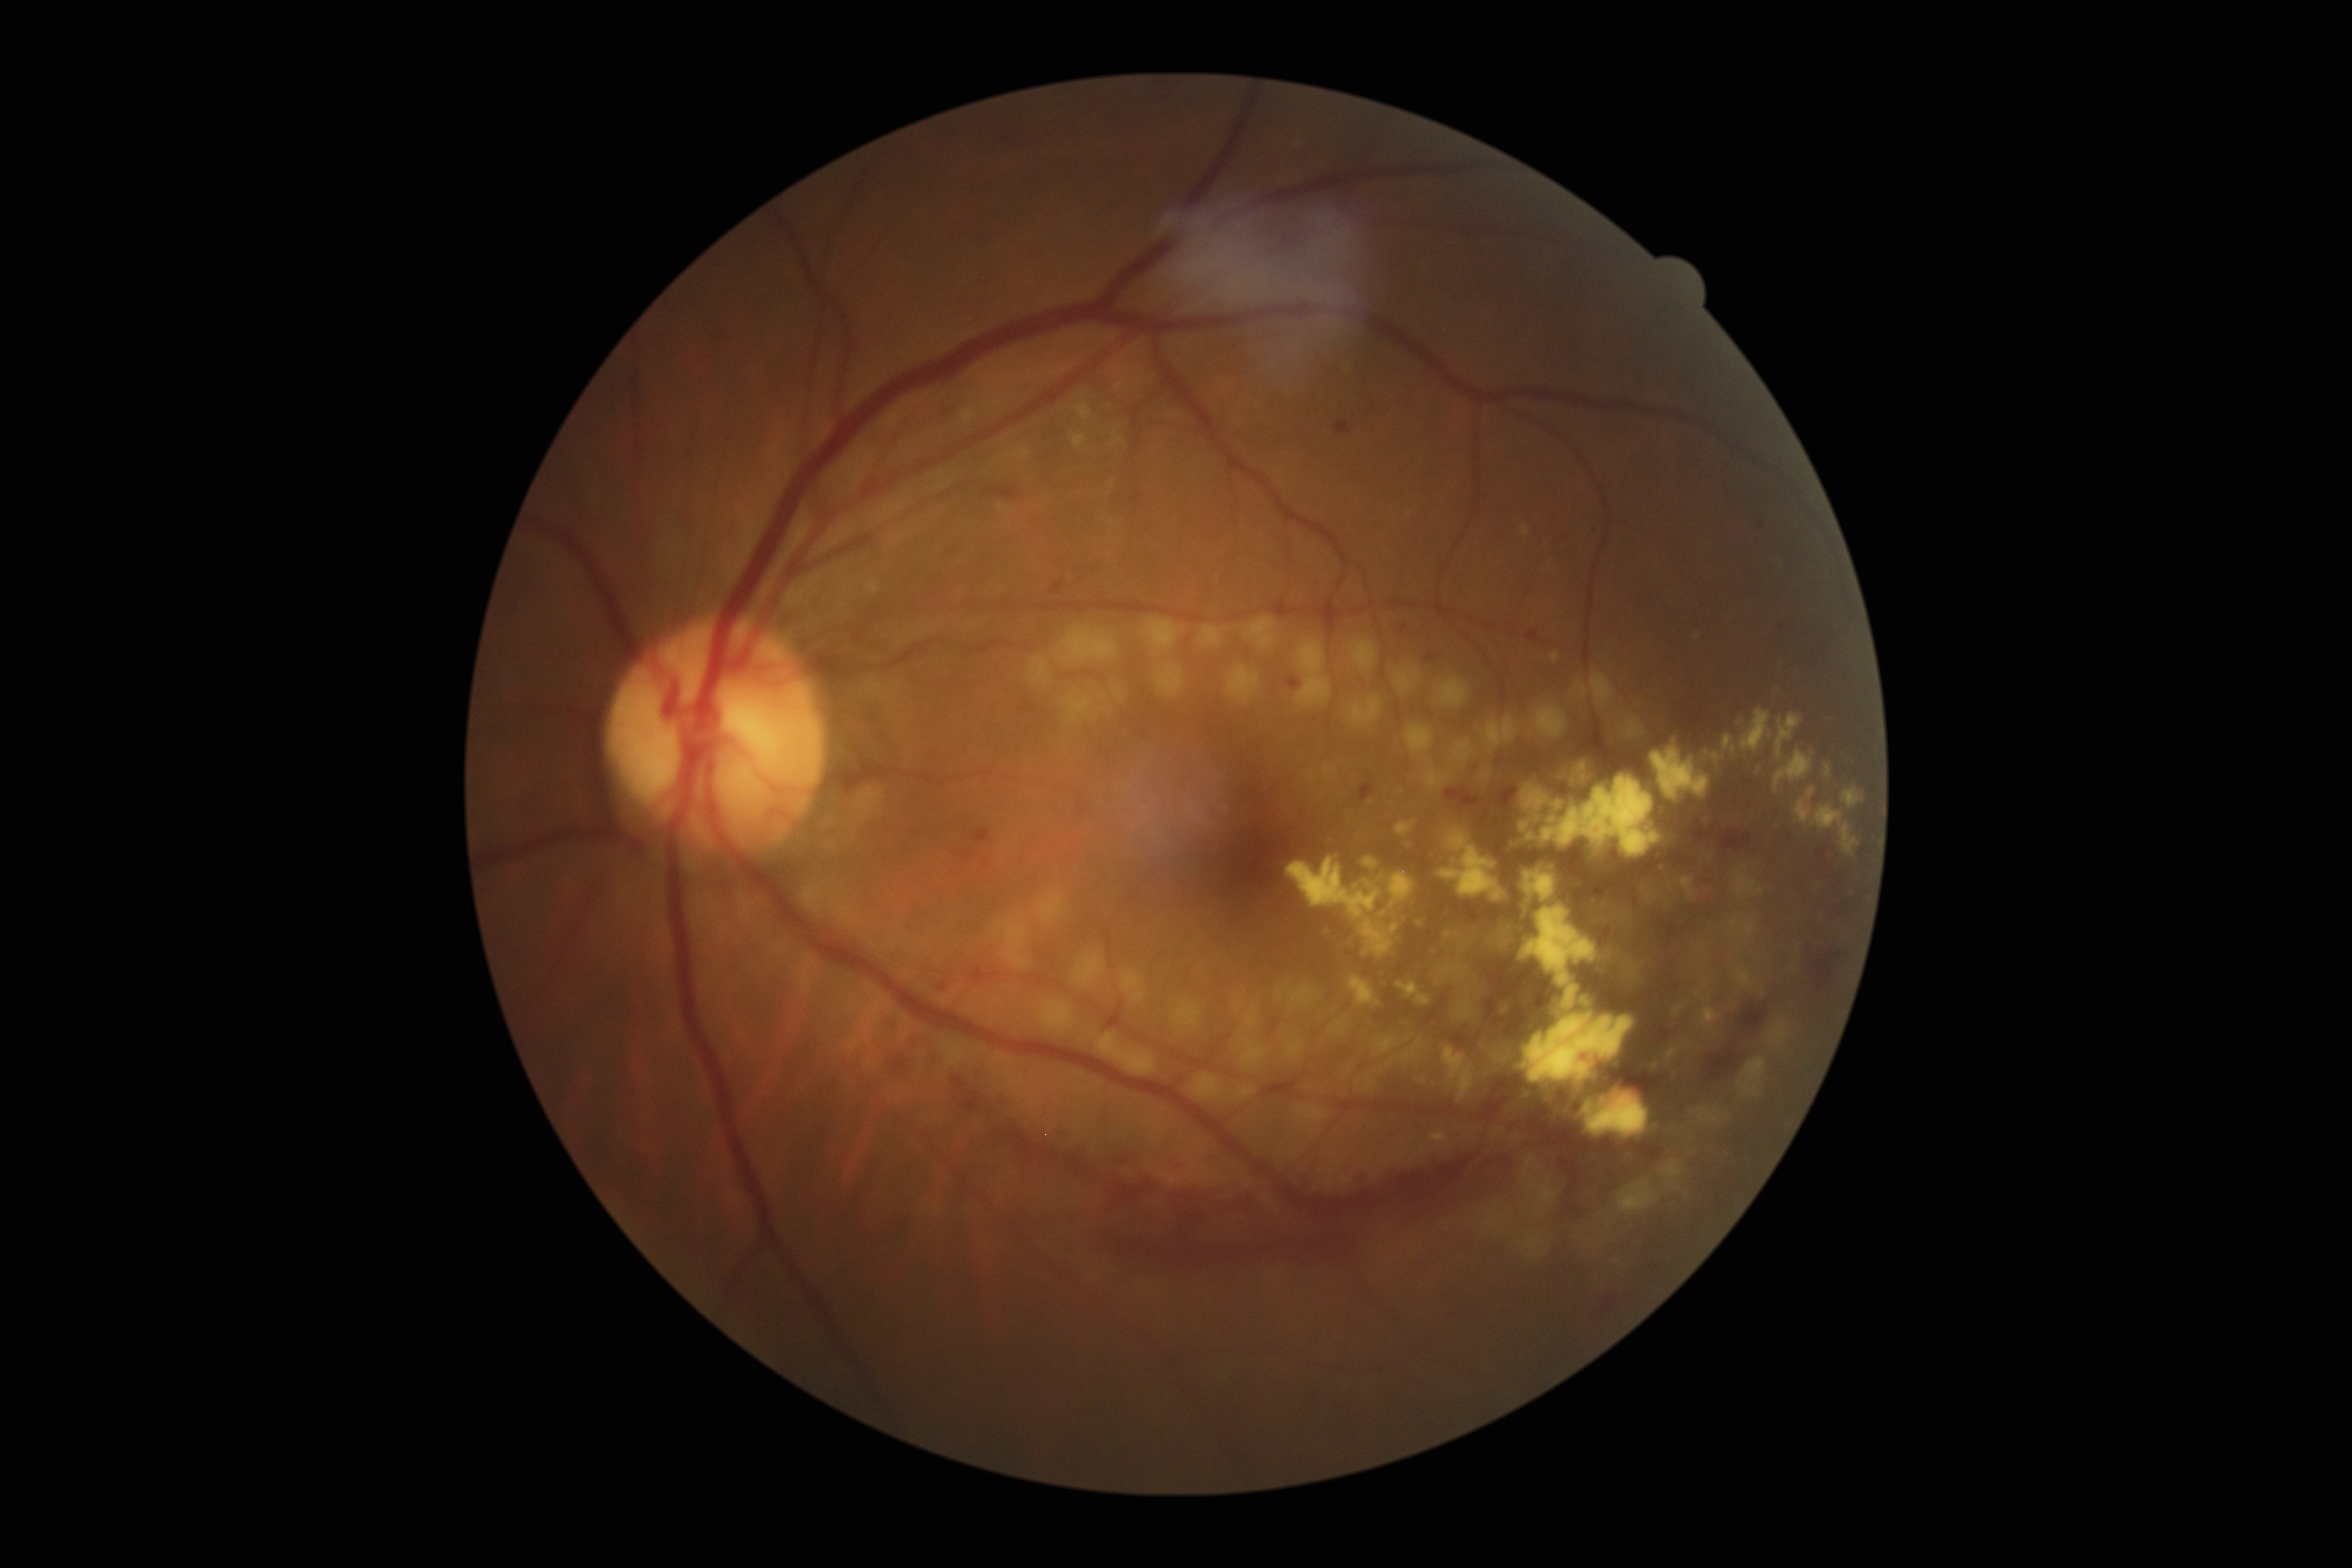 retinopathy grade: PDR (4) | DR class: proliferative diabetic retinopathy.